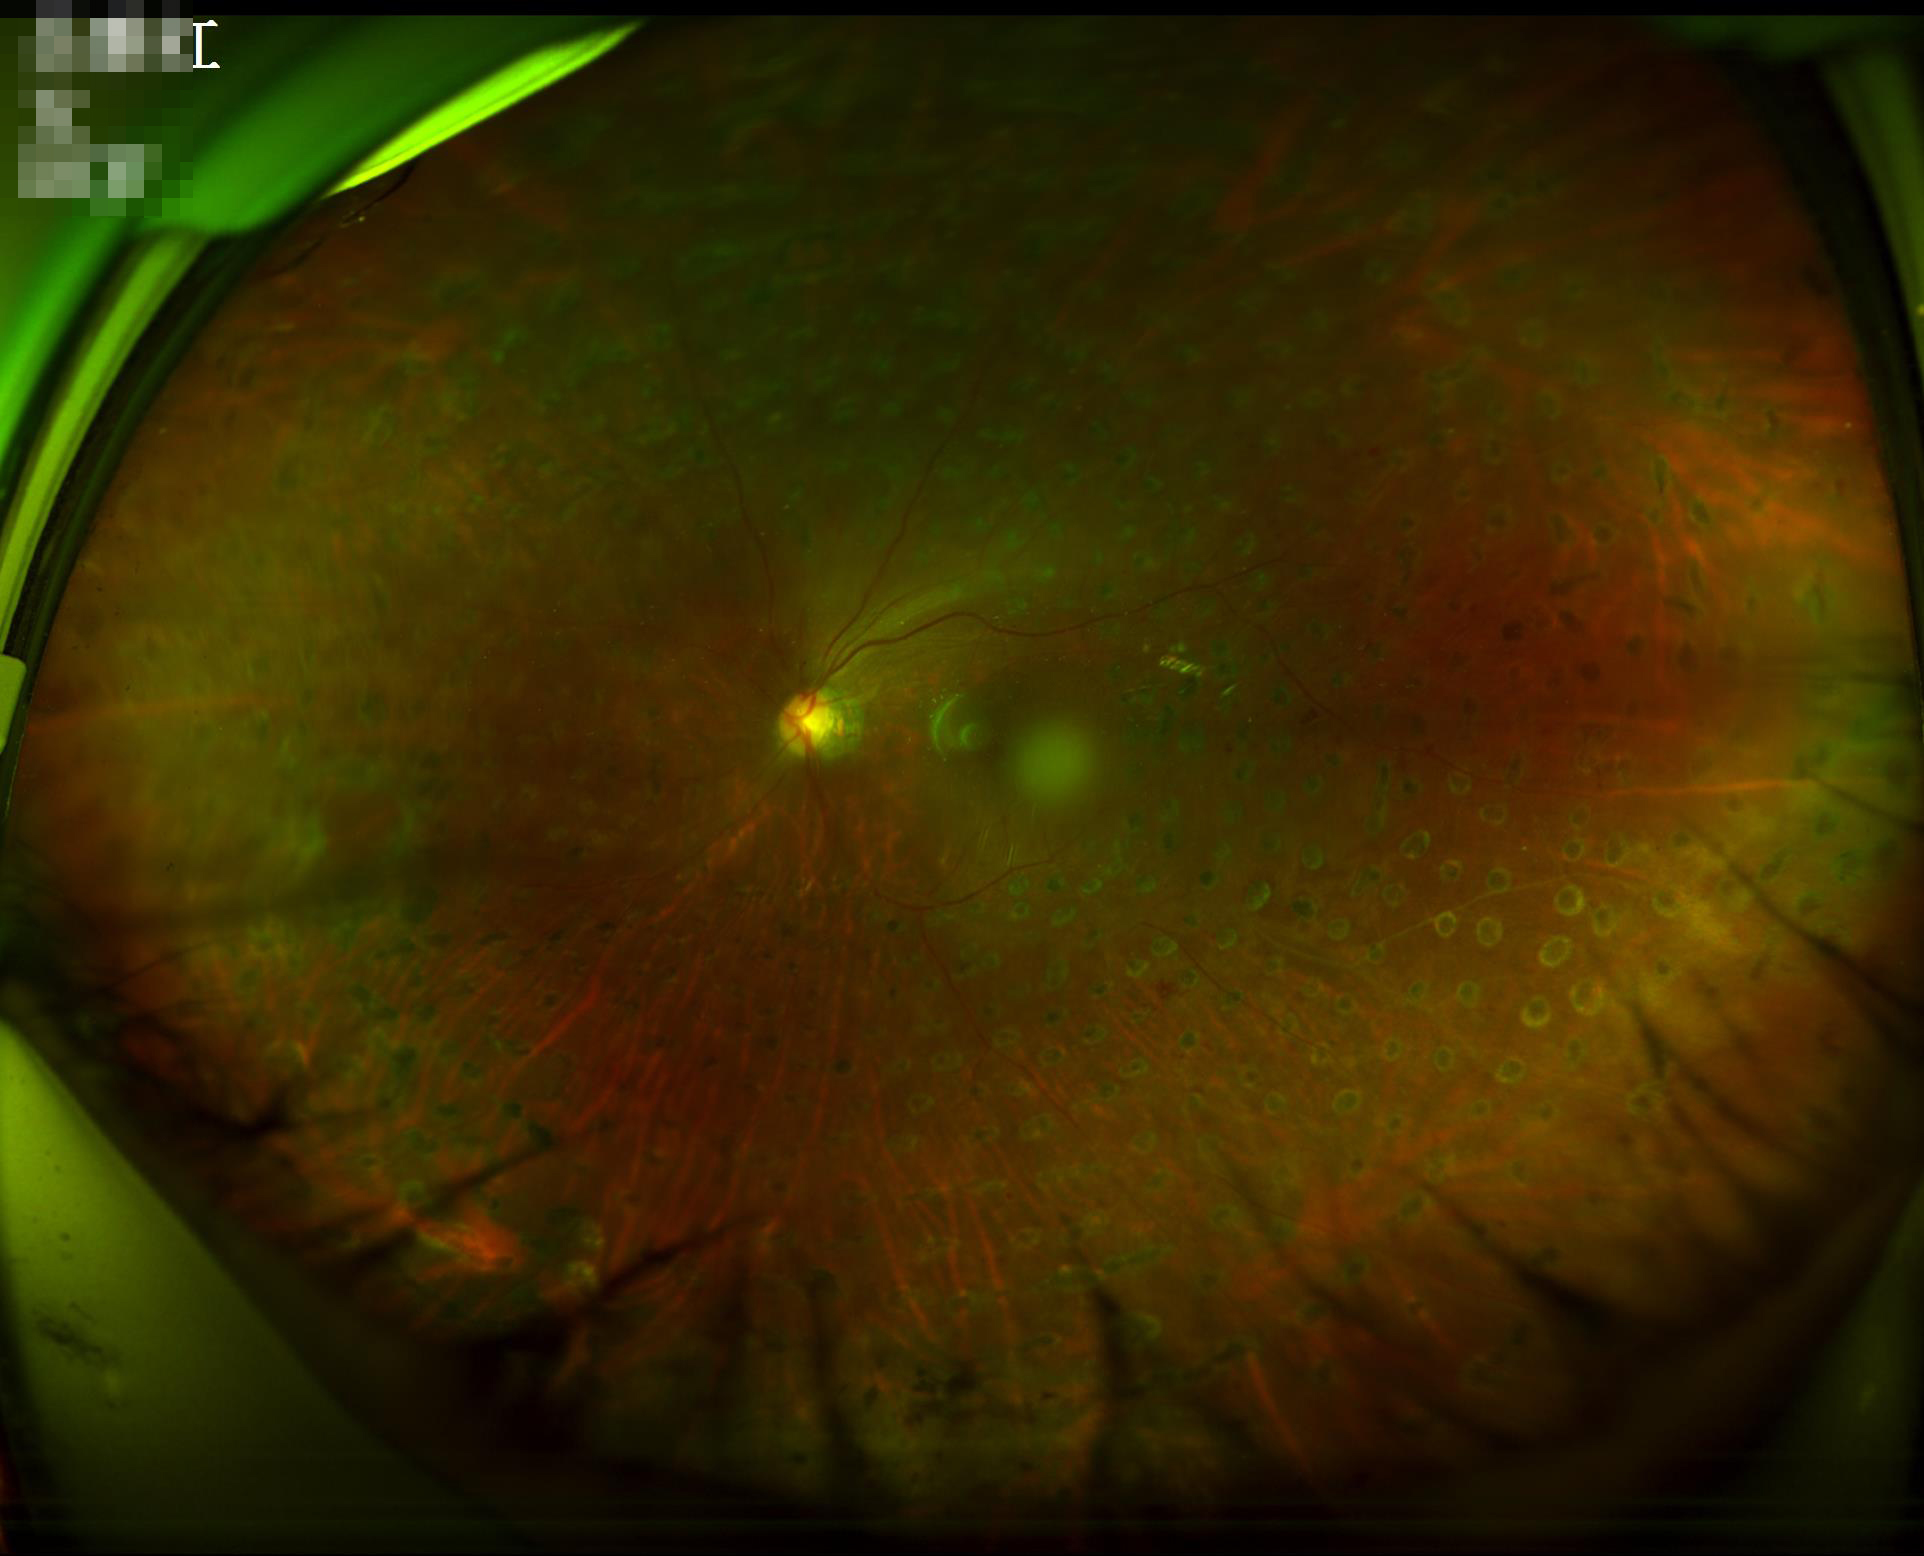

Acceptable image quality. Illumination is even. Narrow intensity range; structures are hard to distinguish.